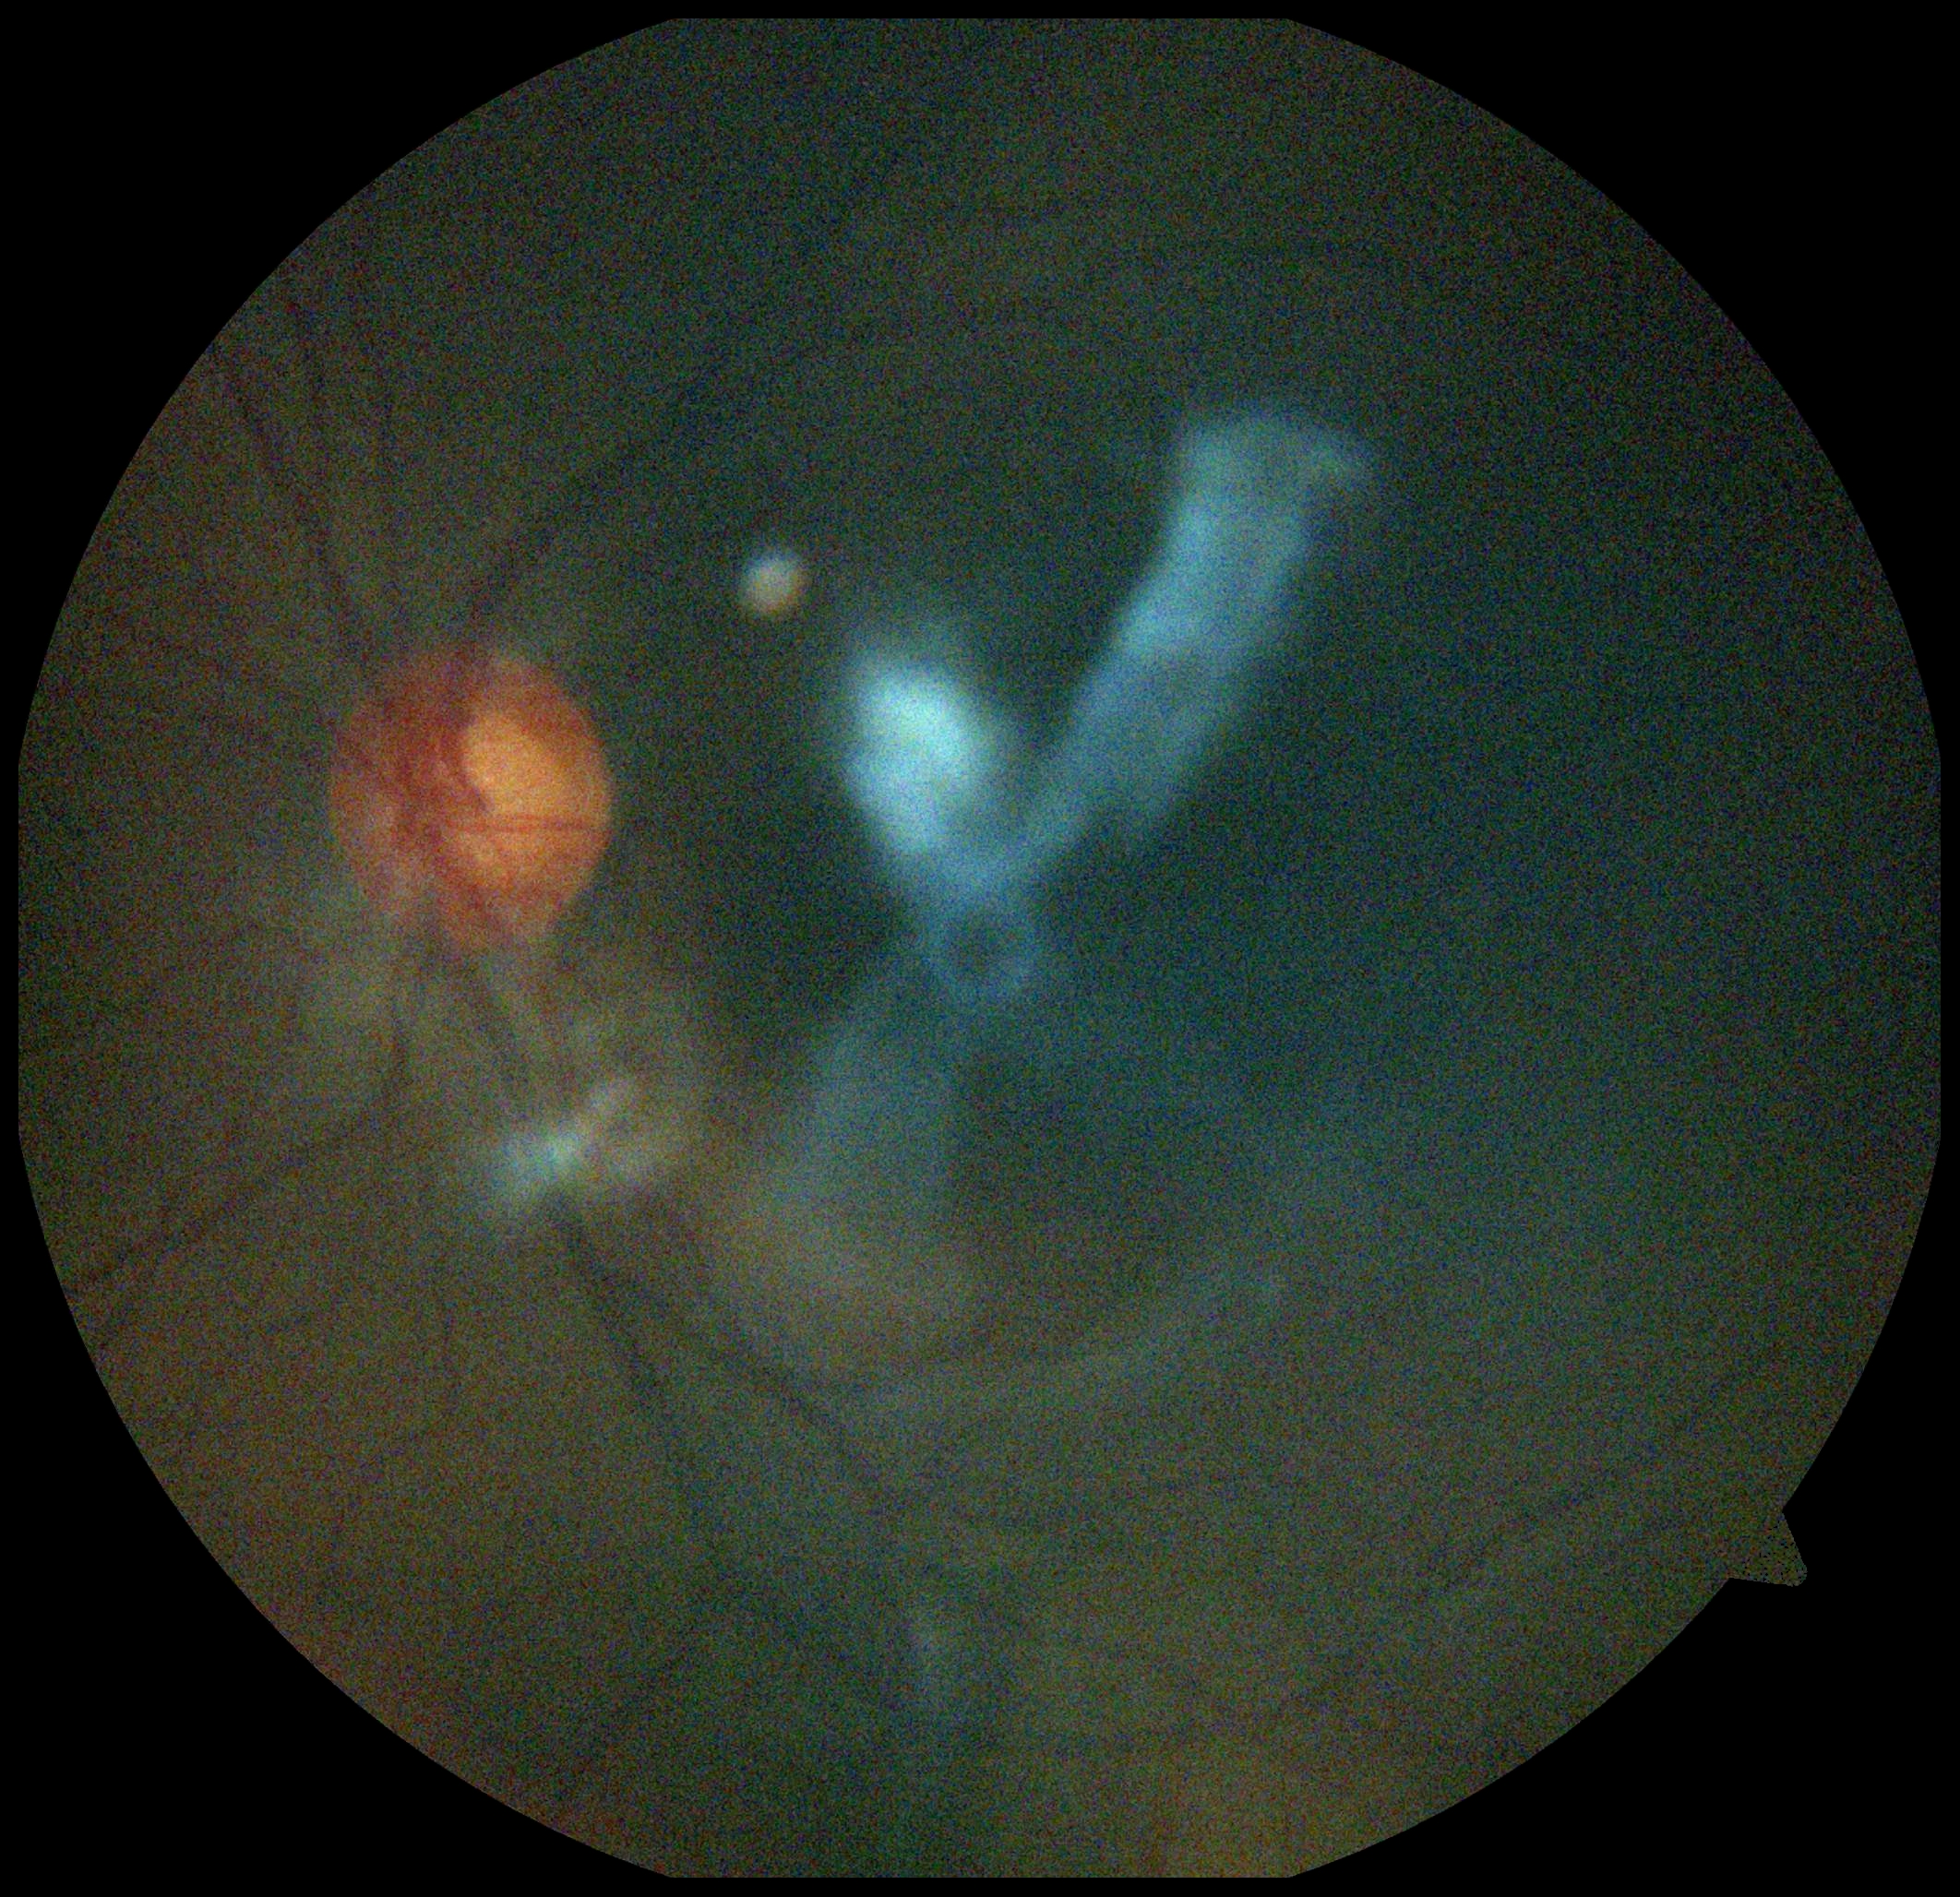 diabetic retinopathy grade = ungradable due to poor image quality.